Non-mydriatic
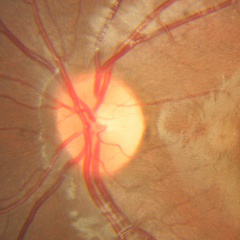 Q: Is glaucoma present?
A: No glaucoma.